Camera: NIDEK AFC-230, no pharmacologic dilation: 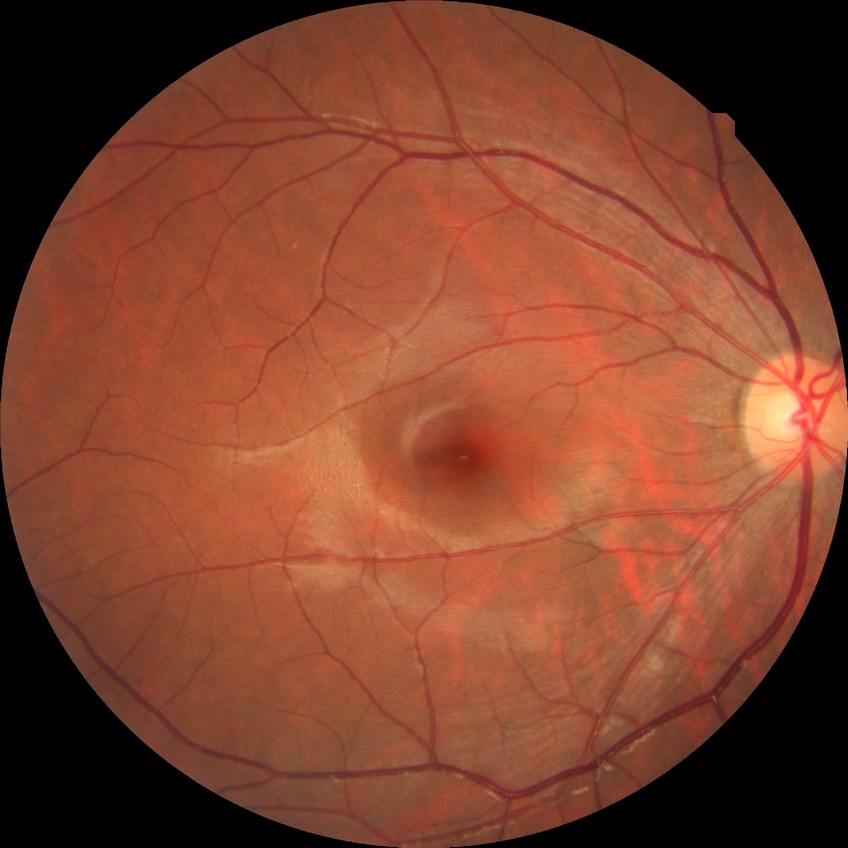 {
  "davis_grade": "no diabetic retinopathy"
}